Acquired with a NIDEK AFC-230, no pharmacologic dilation
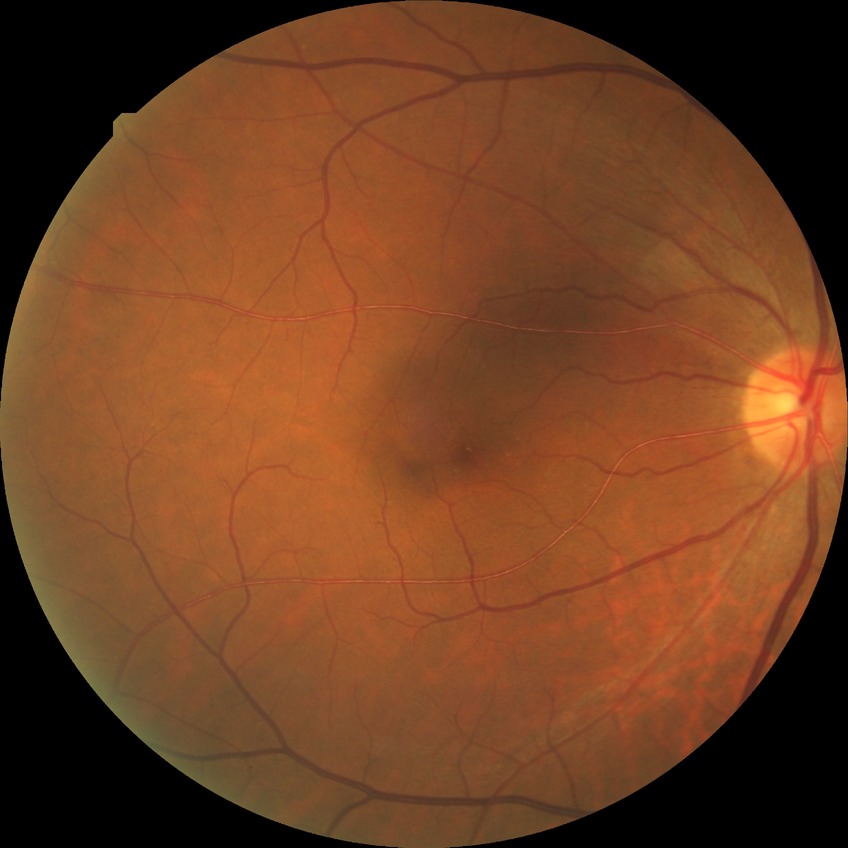 davis_grade: NDR (no diabetic retinopathy)